DR severity per modified Davis staging:
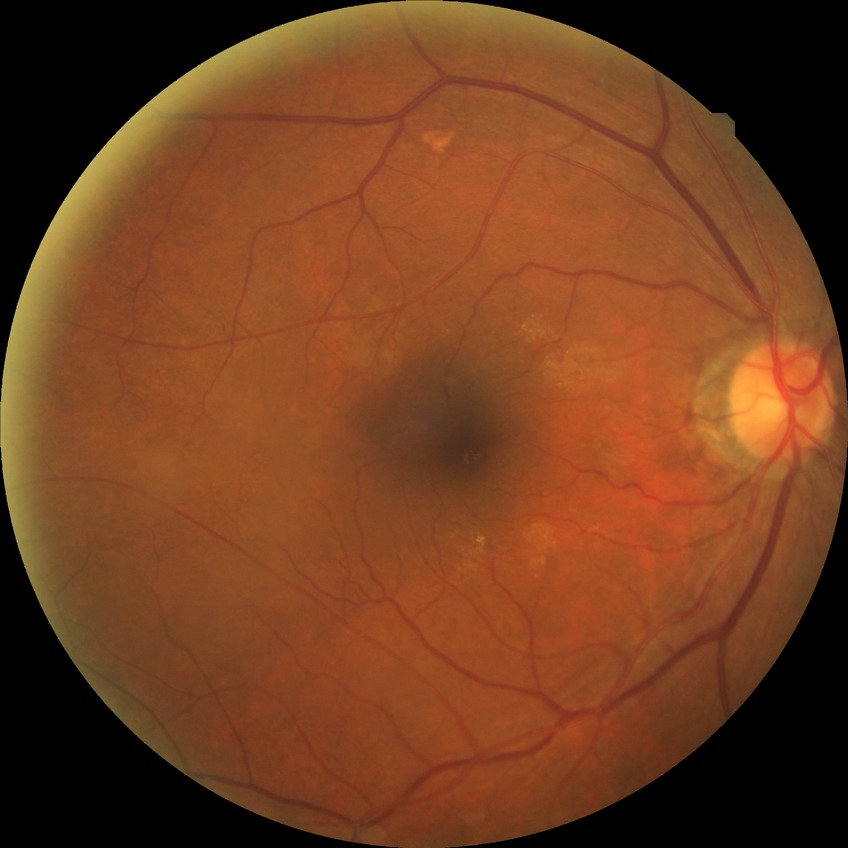
diabetic retinopathy severity = no diabetic retinopathy